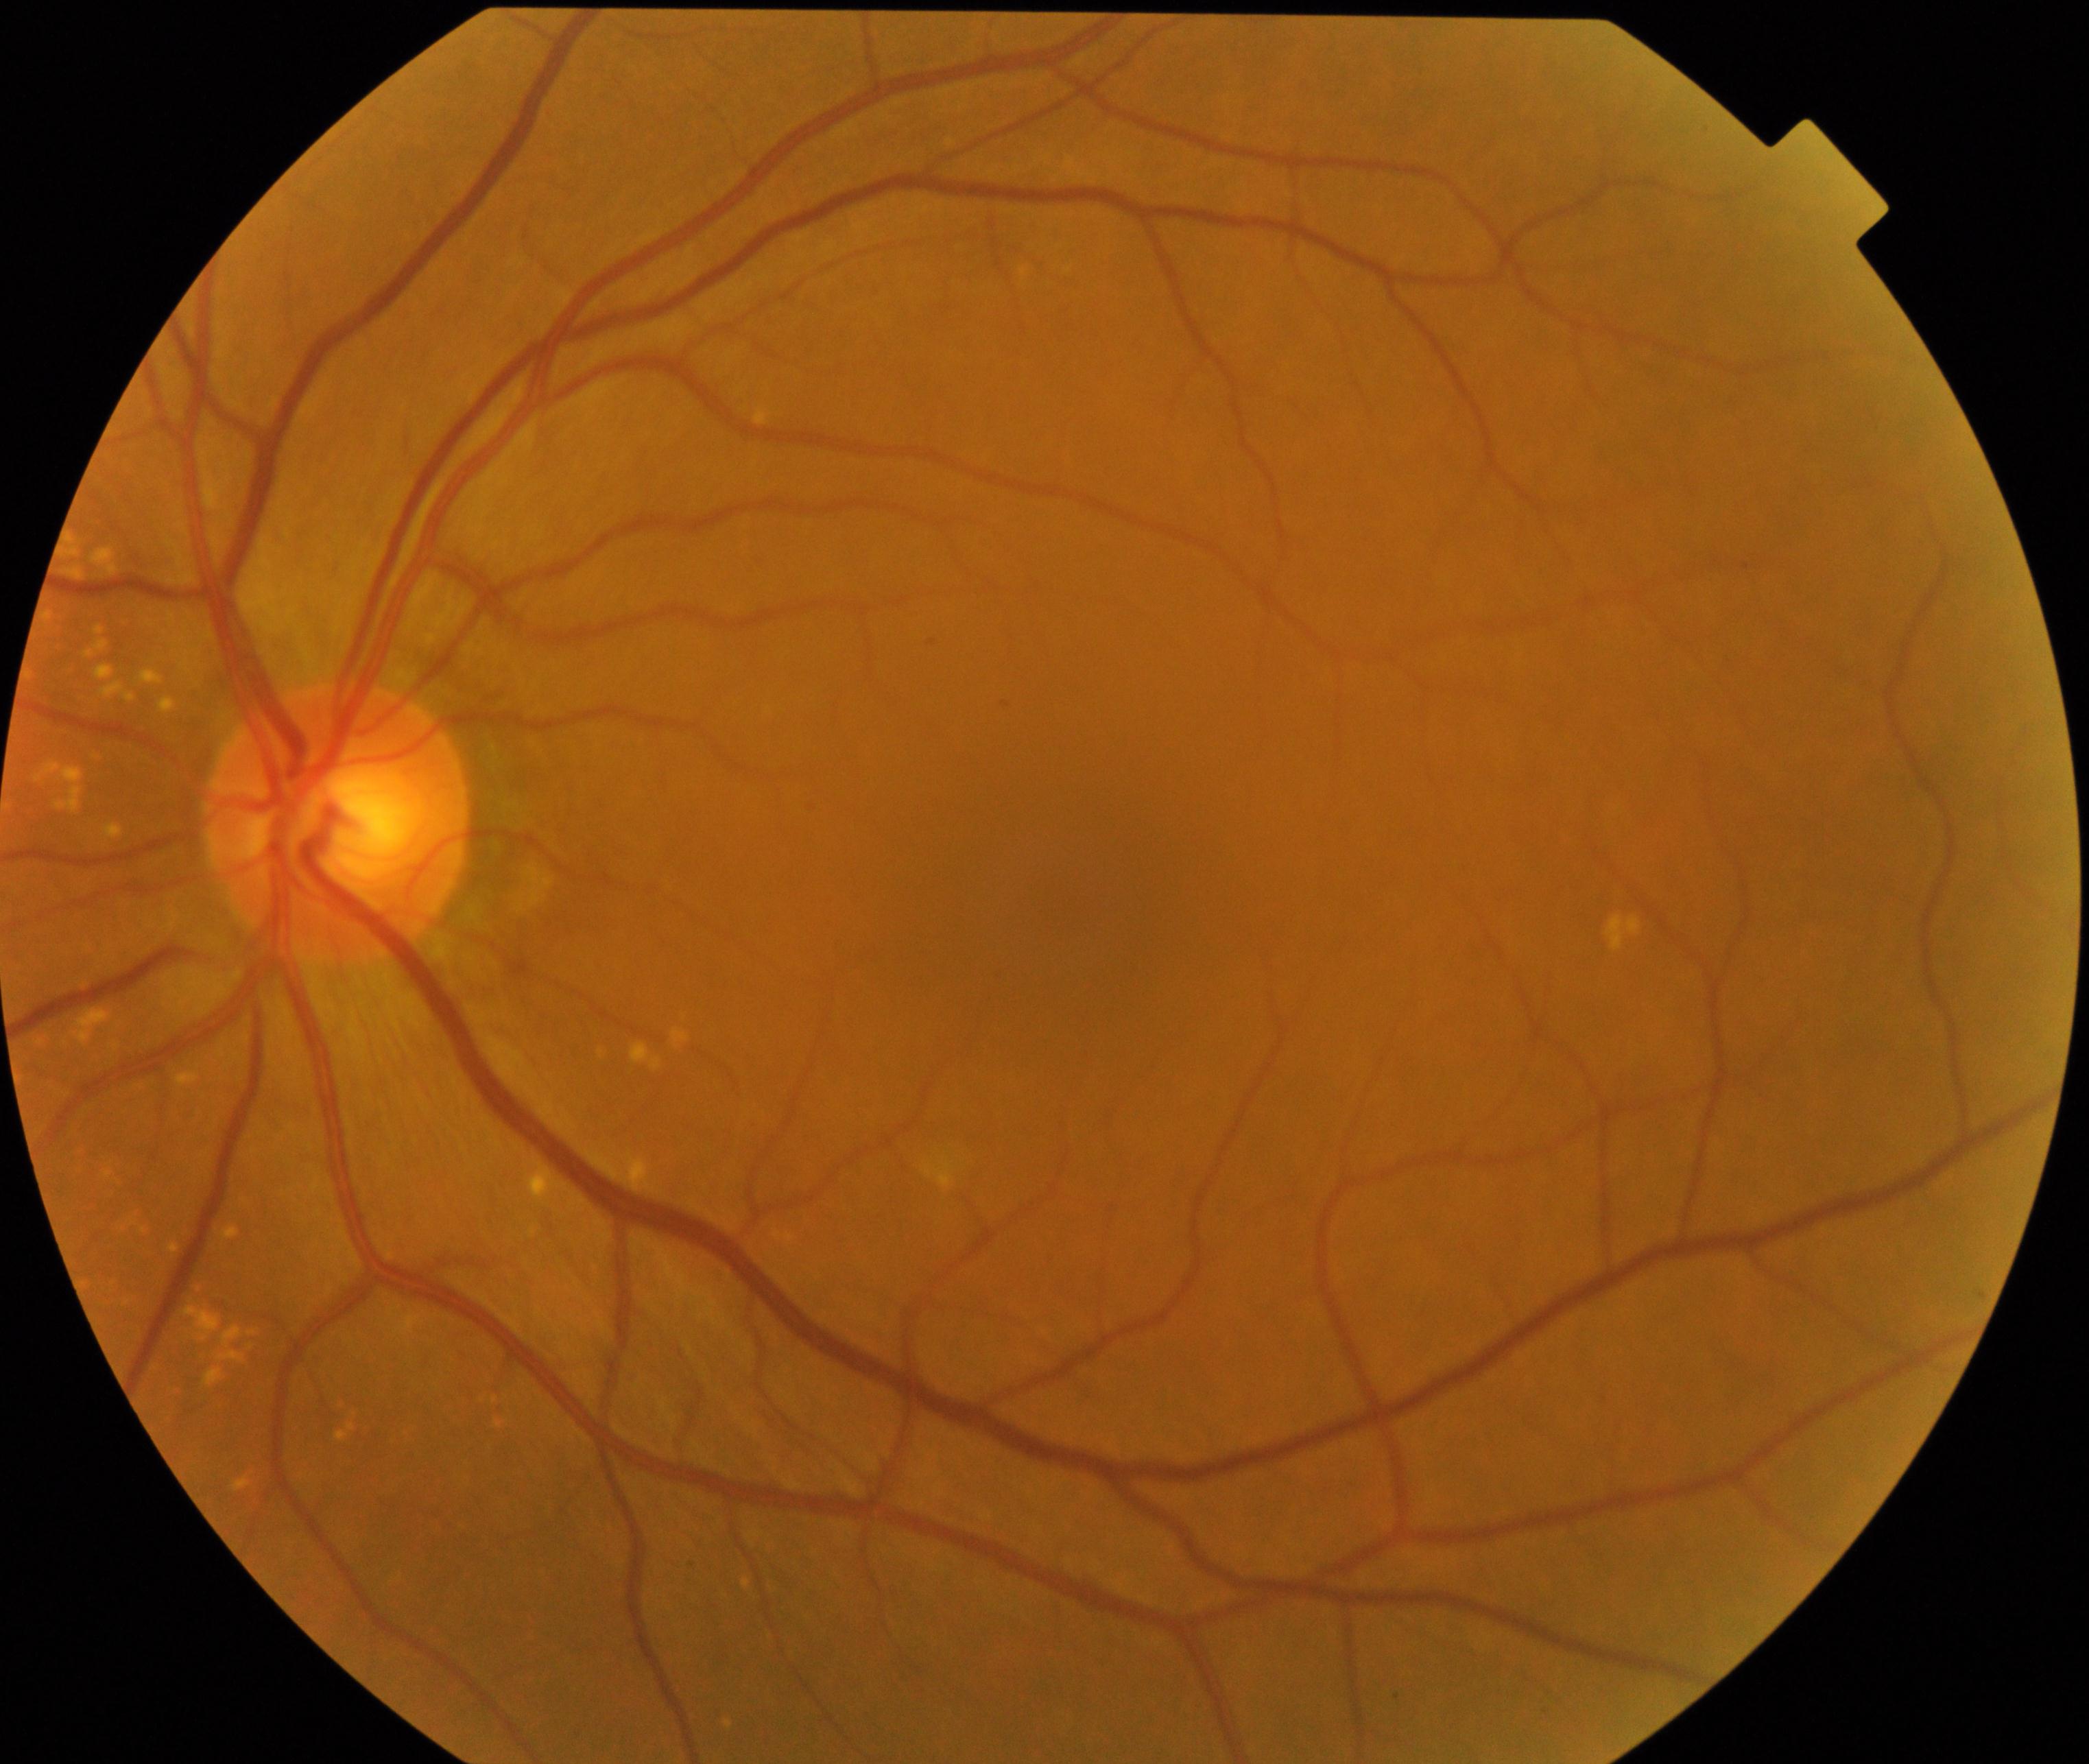
Impression: yellow-white spots or flecks.